240 x 240 pixels. Acquired with a Nidek AFC-330: 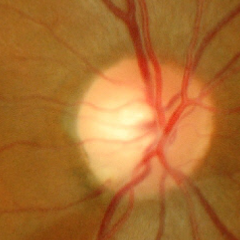
Q: What stage of glaucoma is present?
A: Yes — early glaucomatous changes.